Image size 1240x1240; wide-field fundus photograph from neonatal ROP screening:
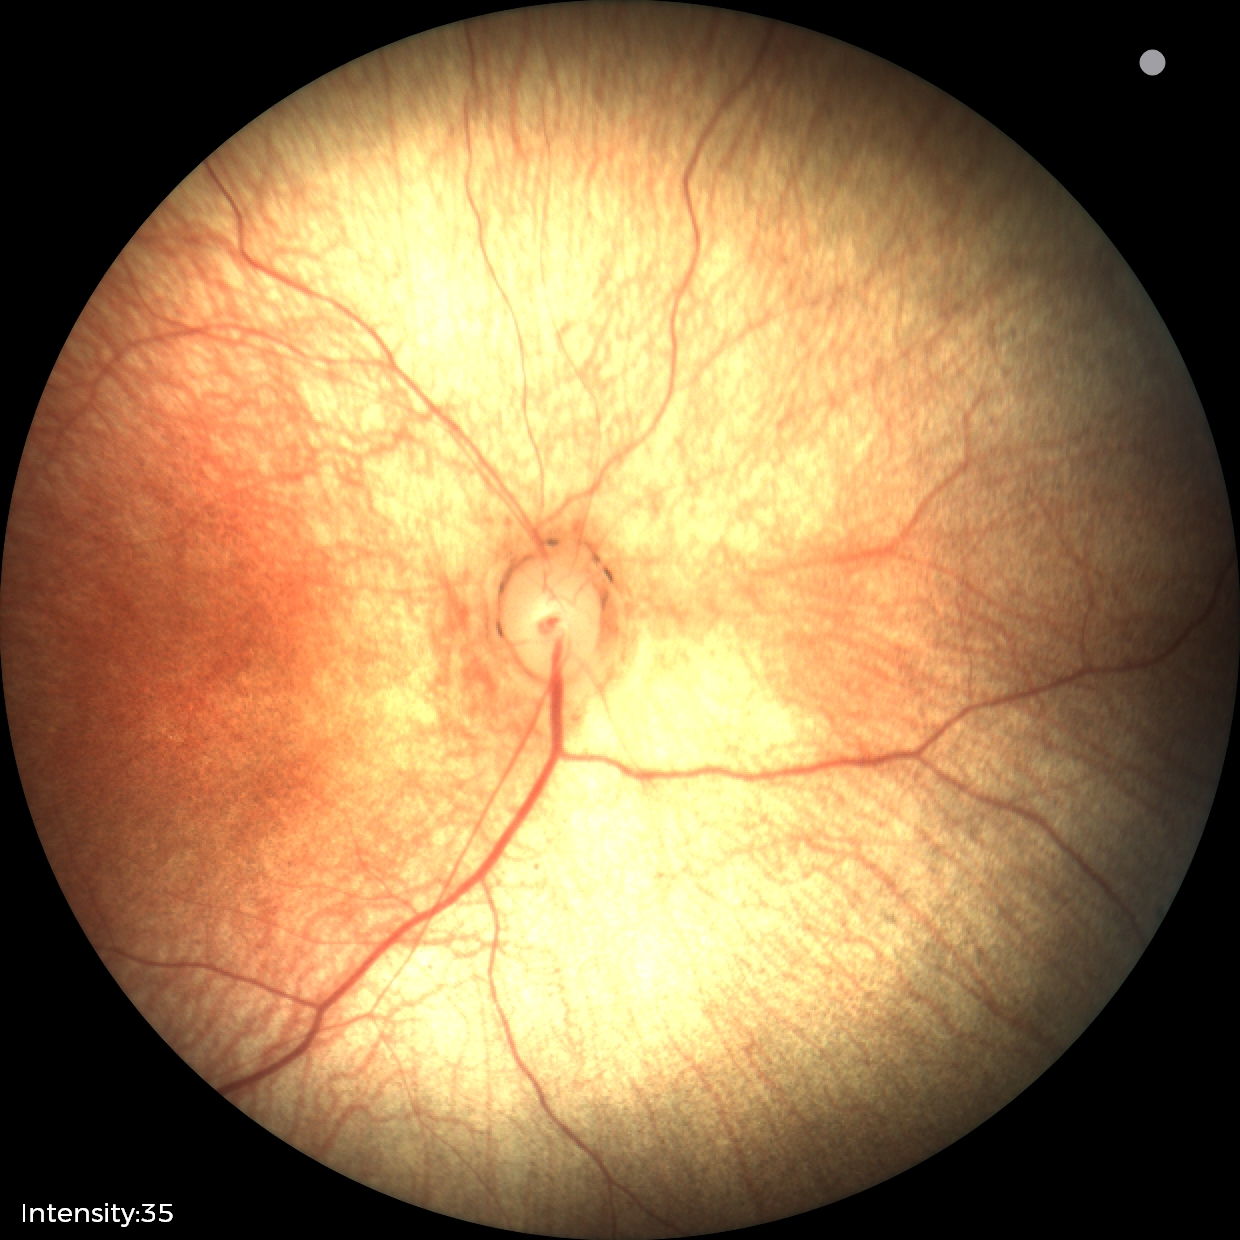 Q: What is the diagnosis from this examination?
A: no abnormal retinal findings